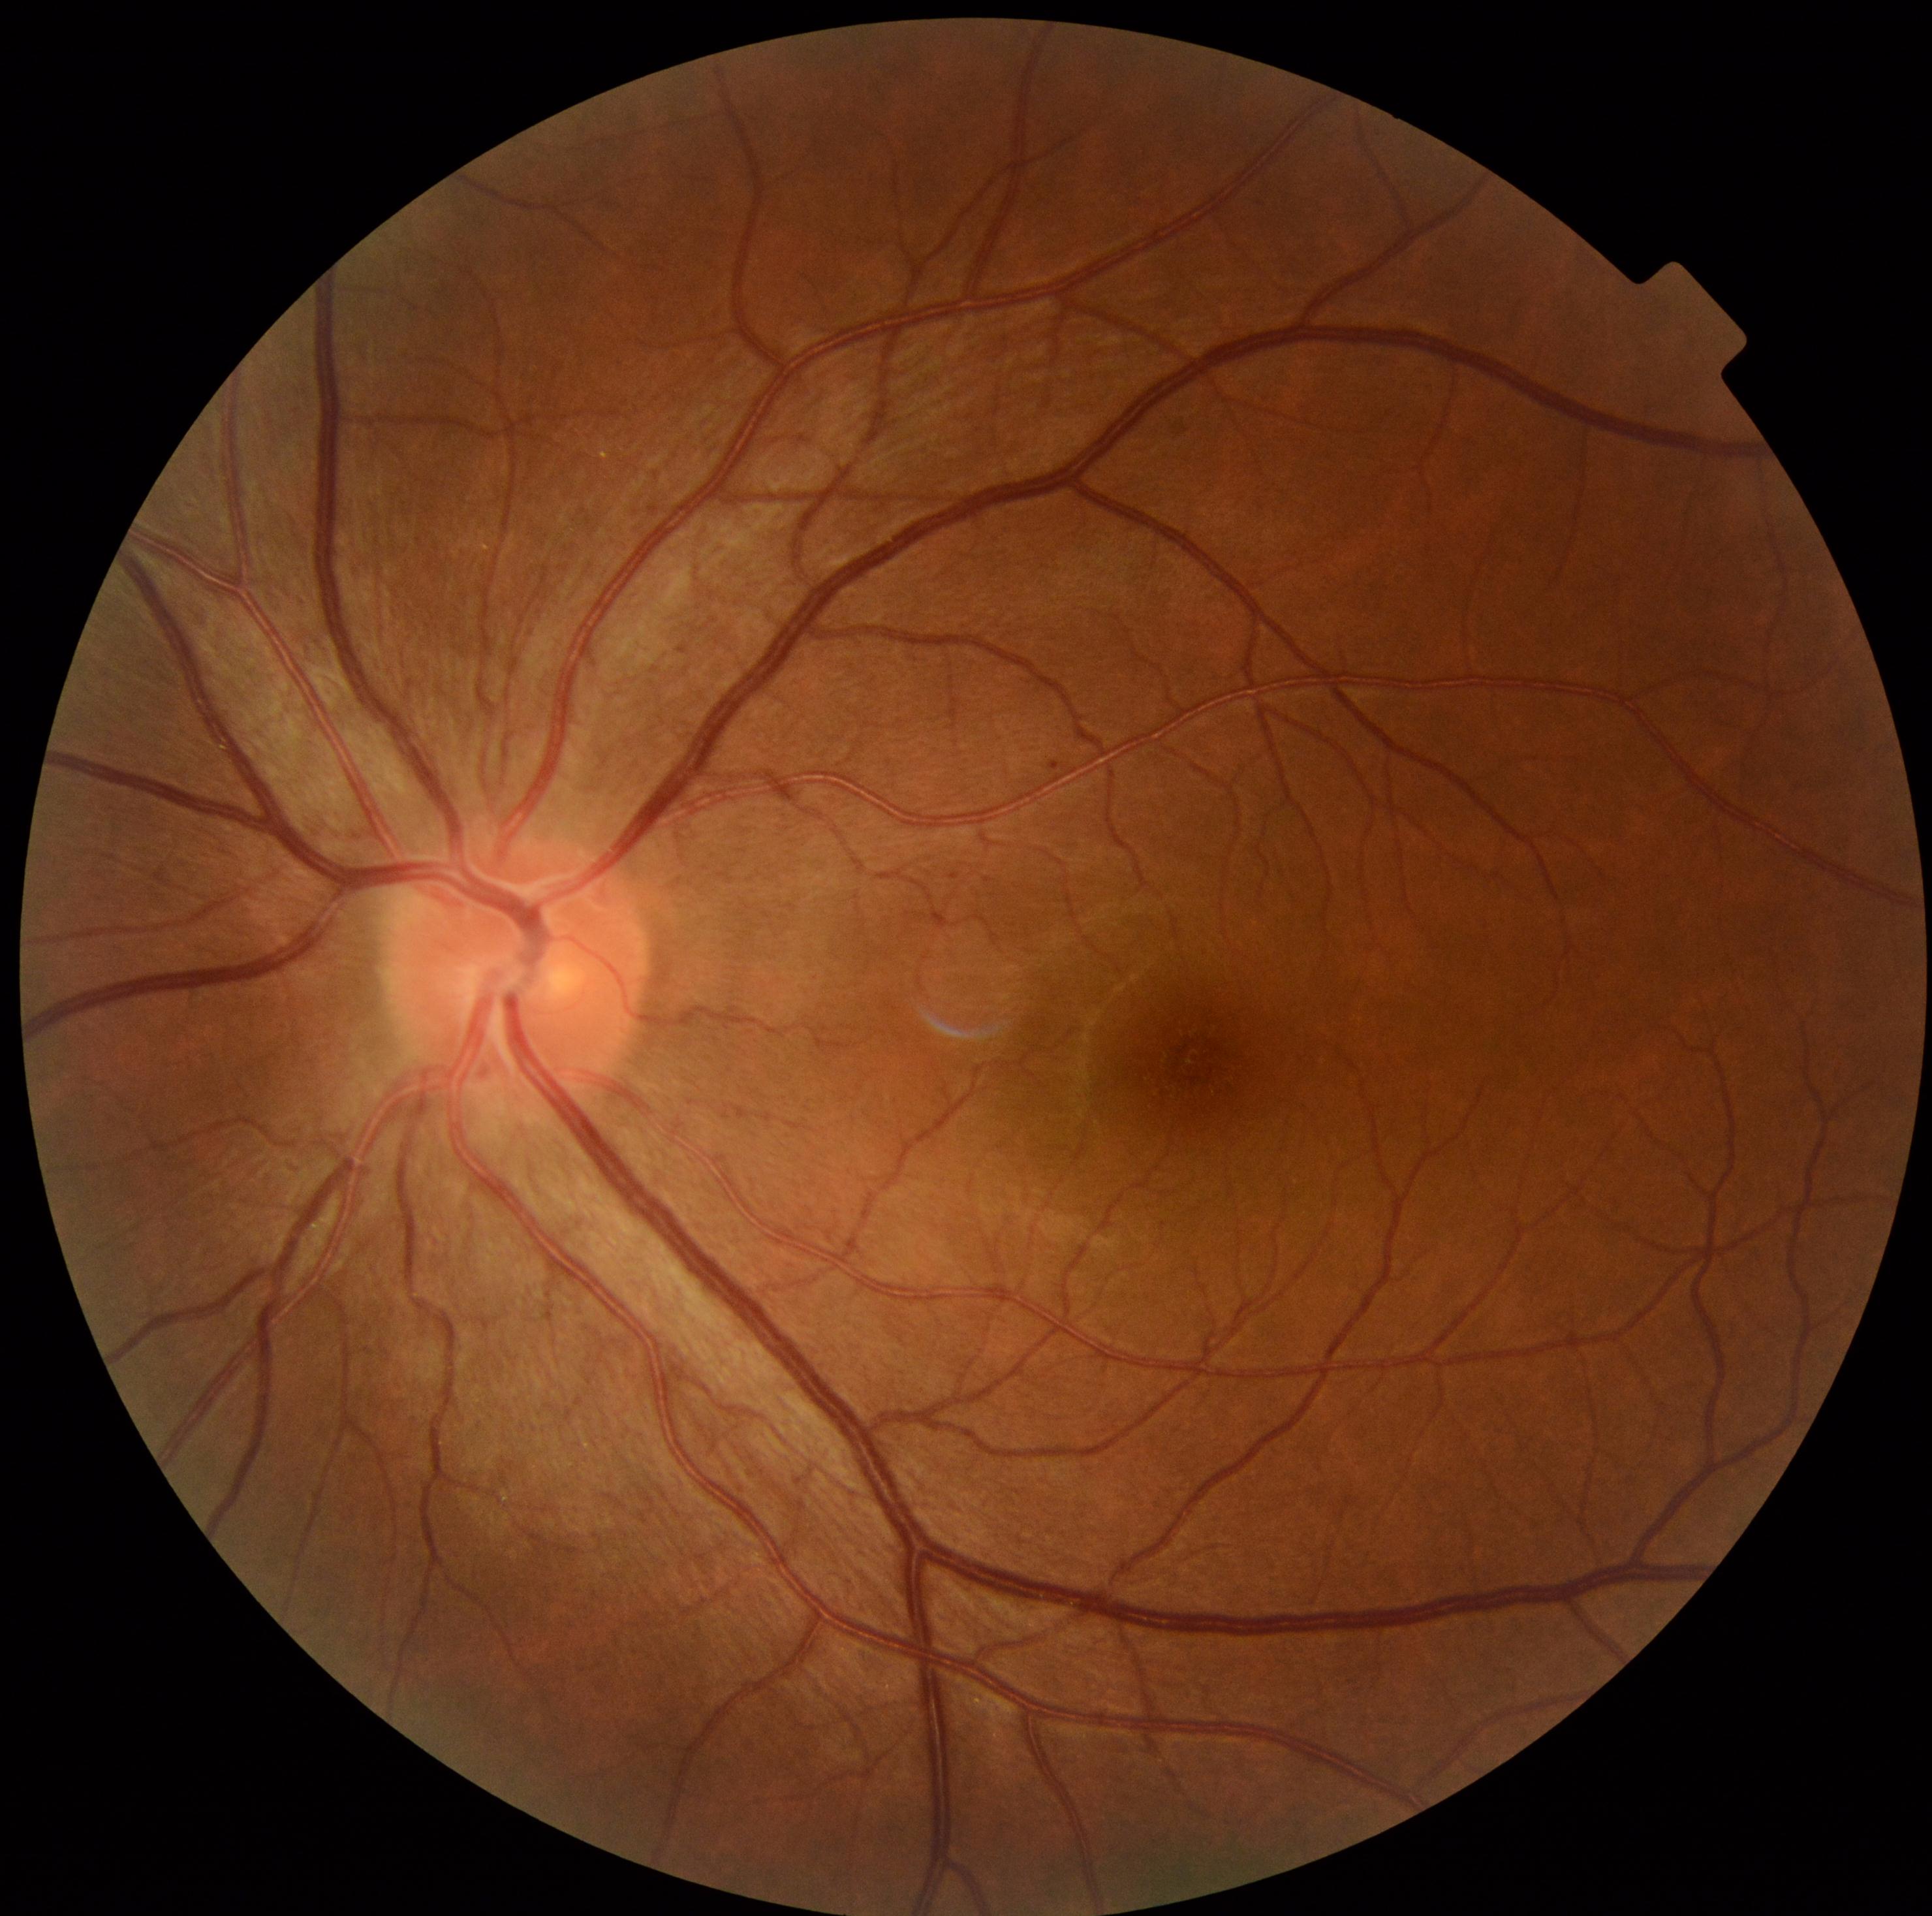
Diabetic retinopathy grade: 1 (mild NPDR).